CFP; 1659x2212; captured on a Remidio Fundus on Phone (FOP) camera: 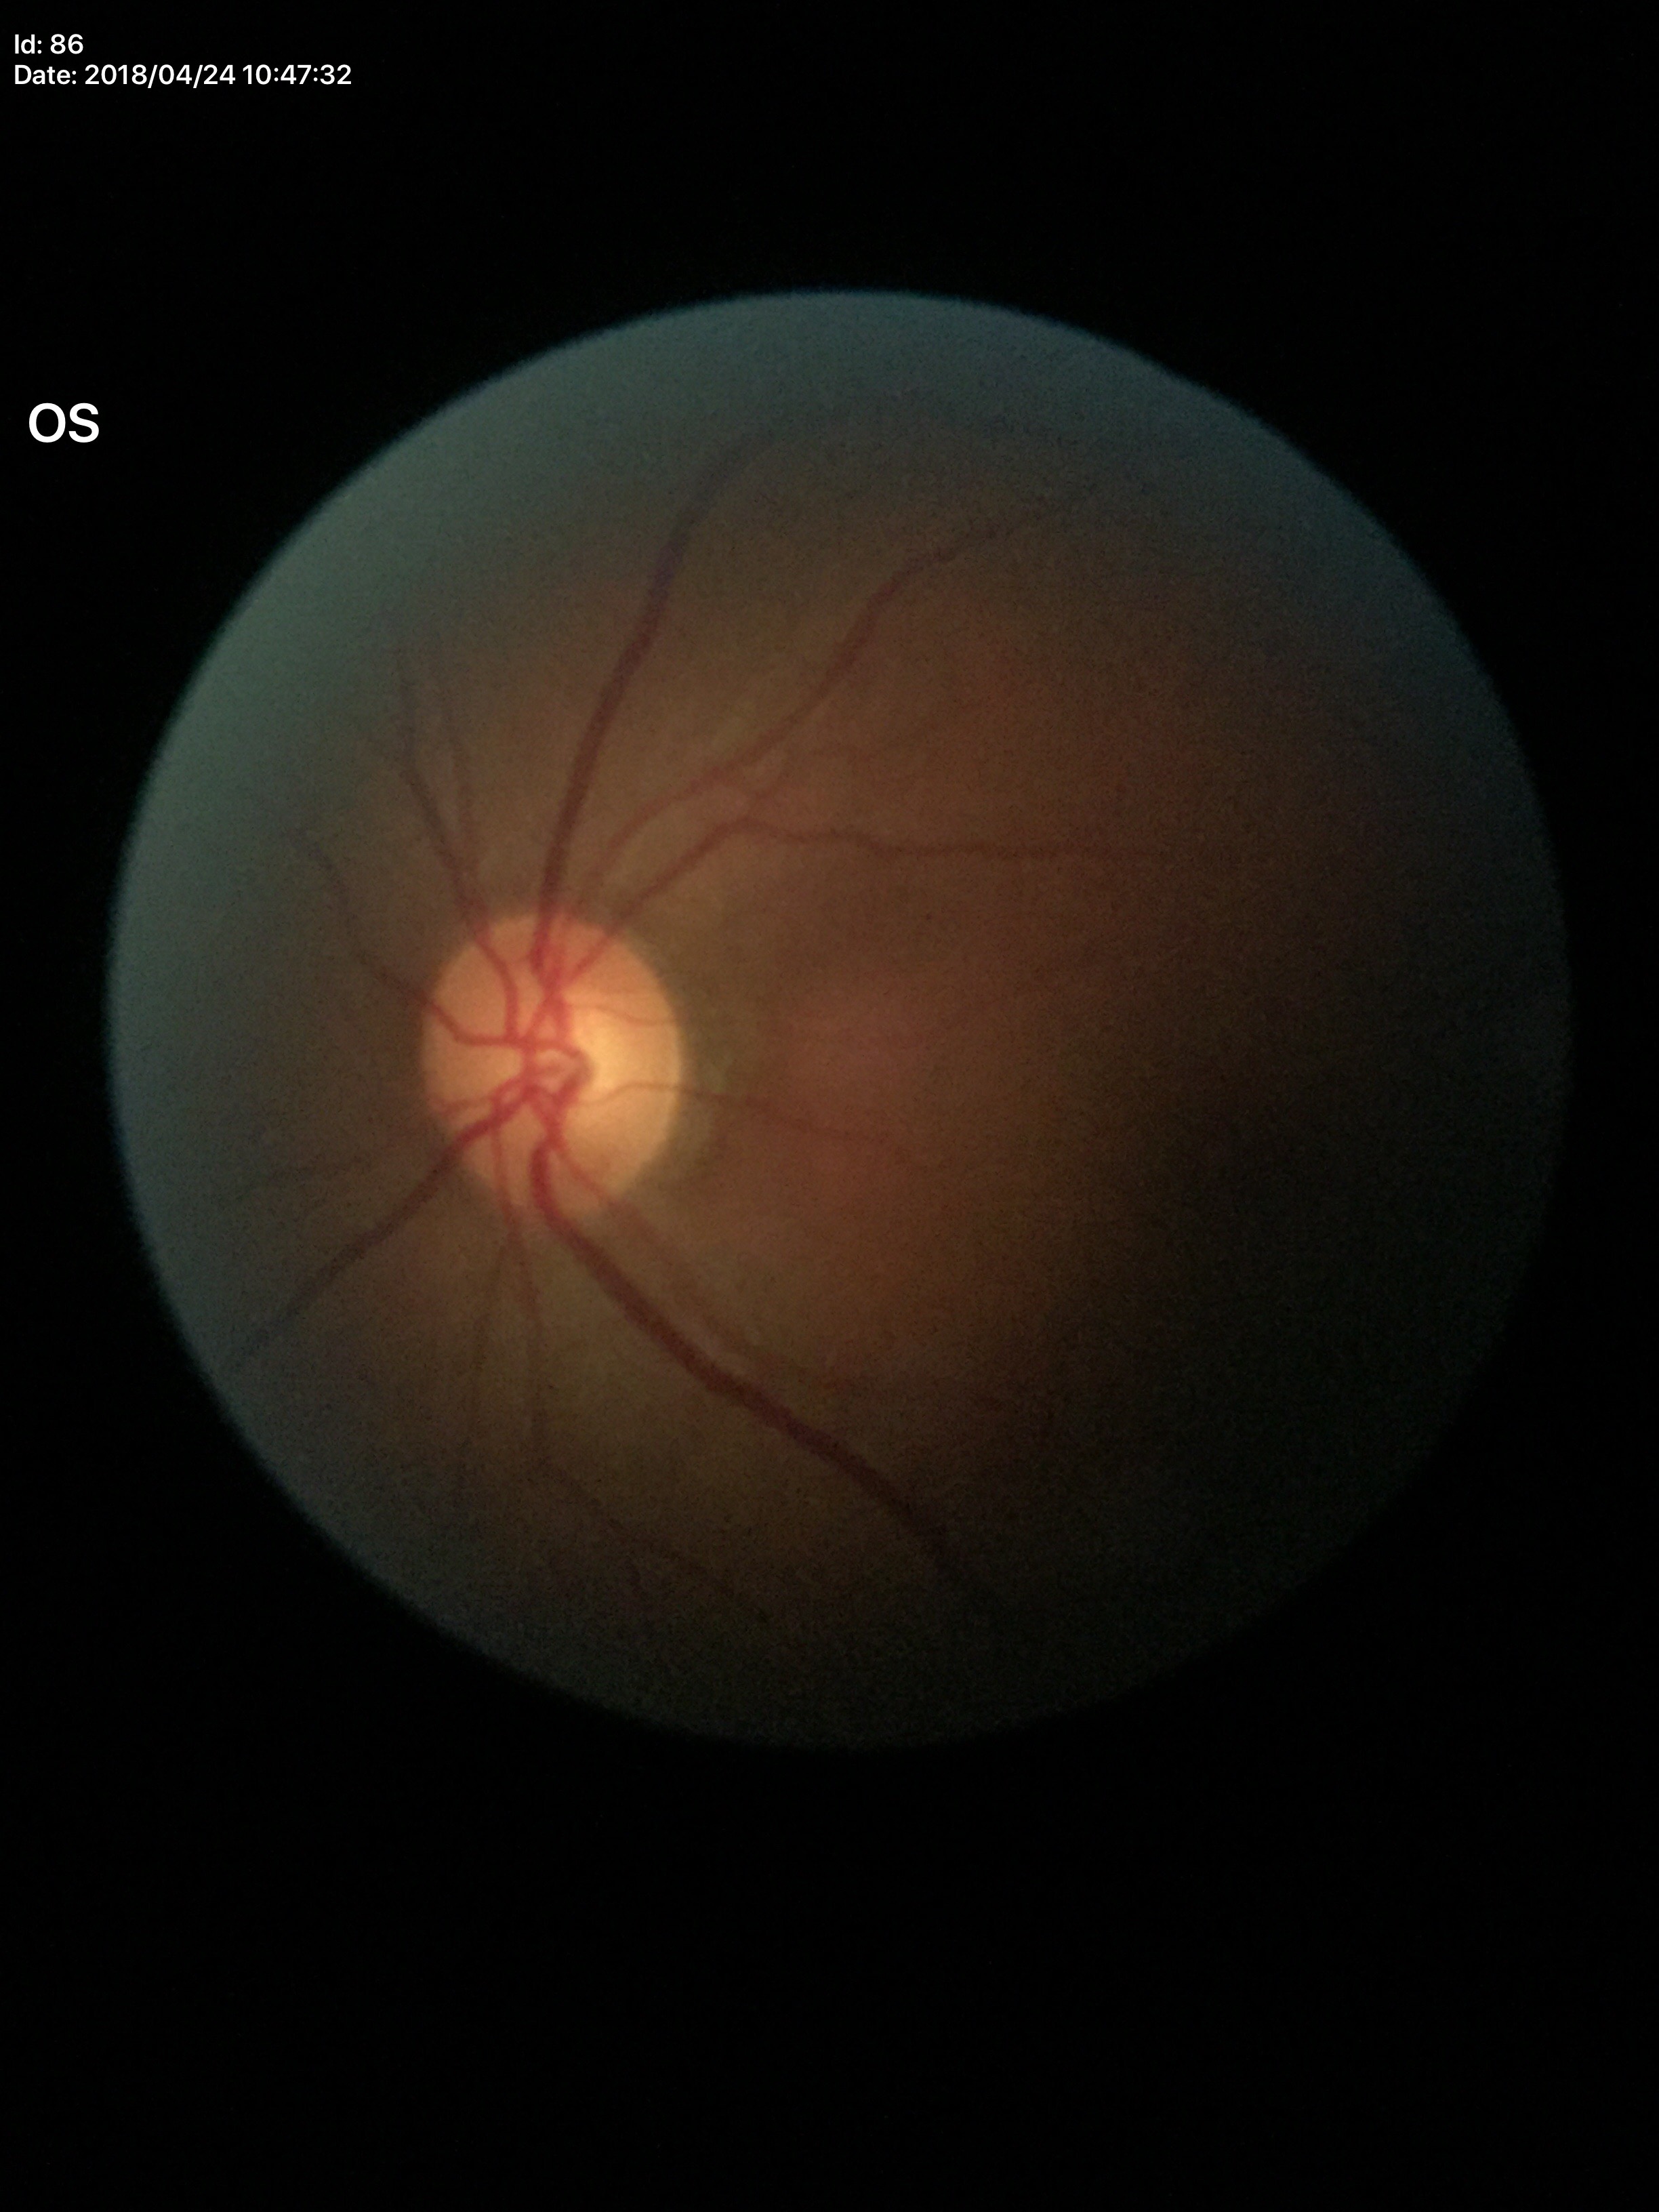 Negative for glaucoma suspicion. VCDR: 0.55.